848x848px · modified Davis grading: 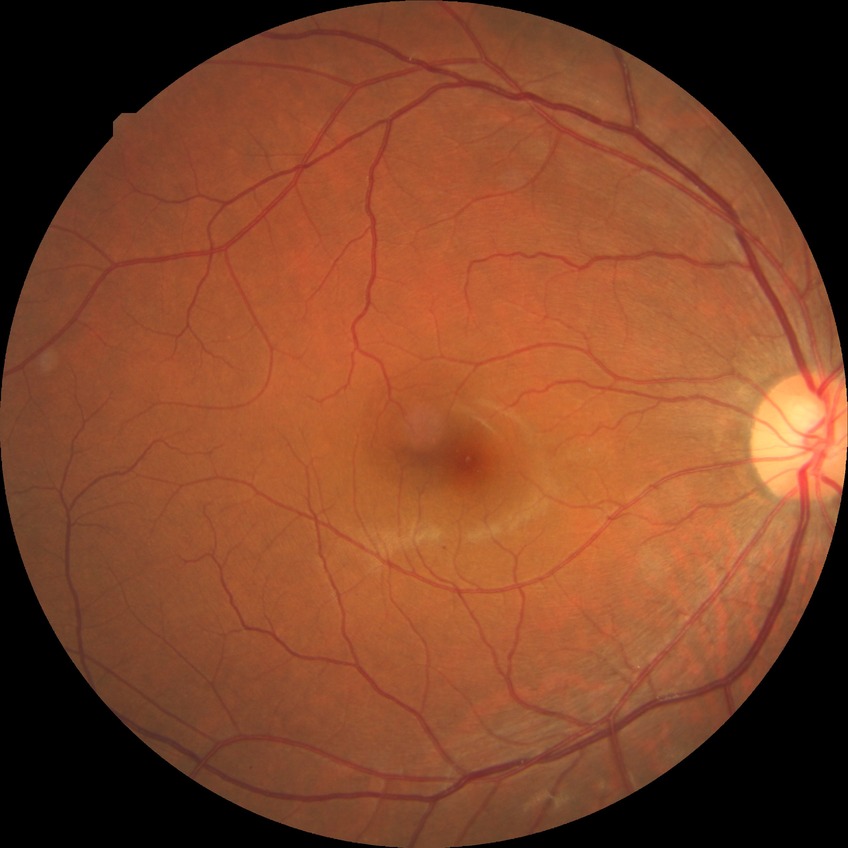
DR class = non-proliferative diabetic retinopathy
modified Davis classification = simple diabetic retinopathy